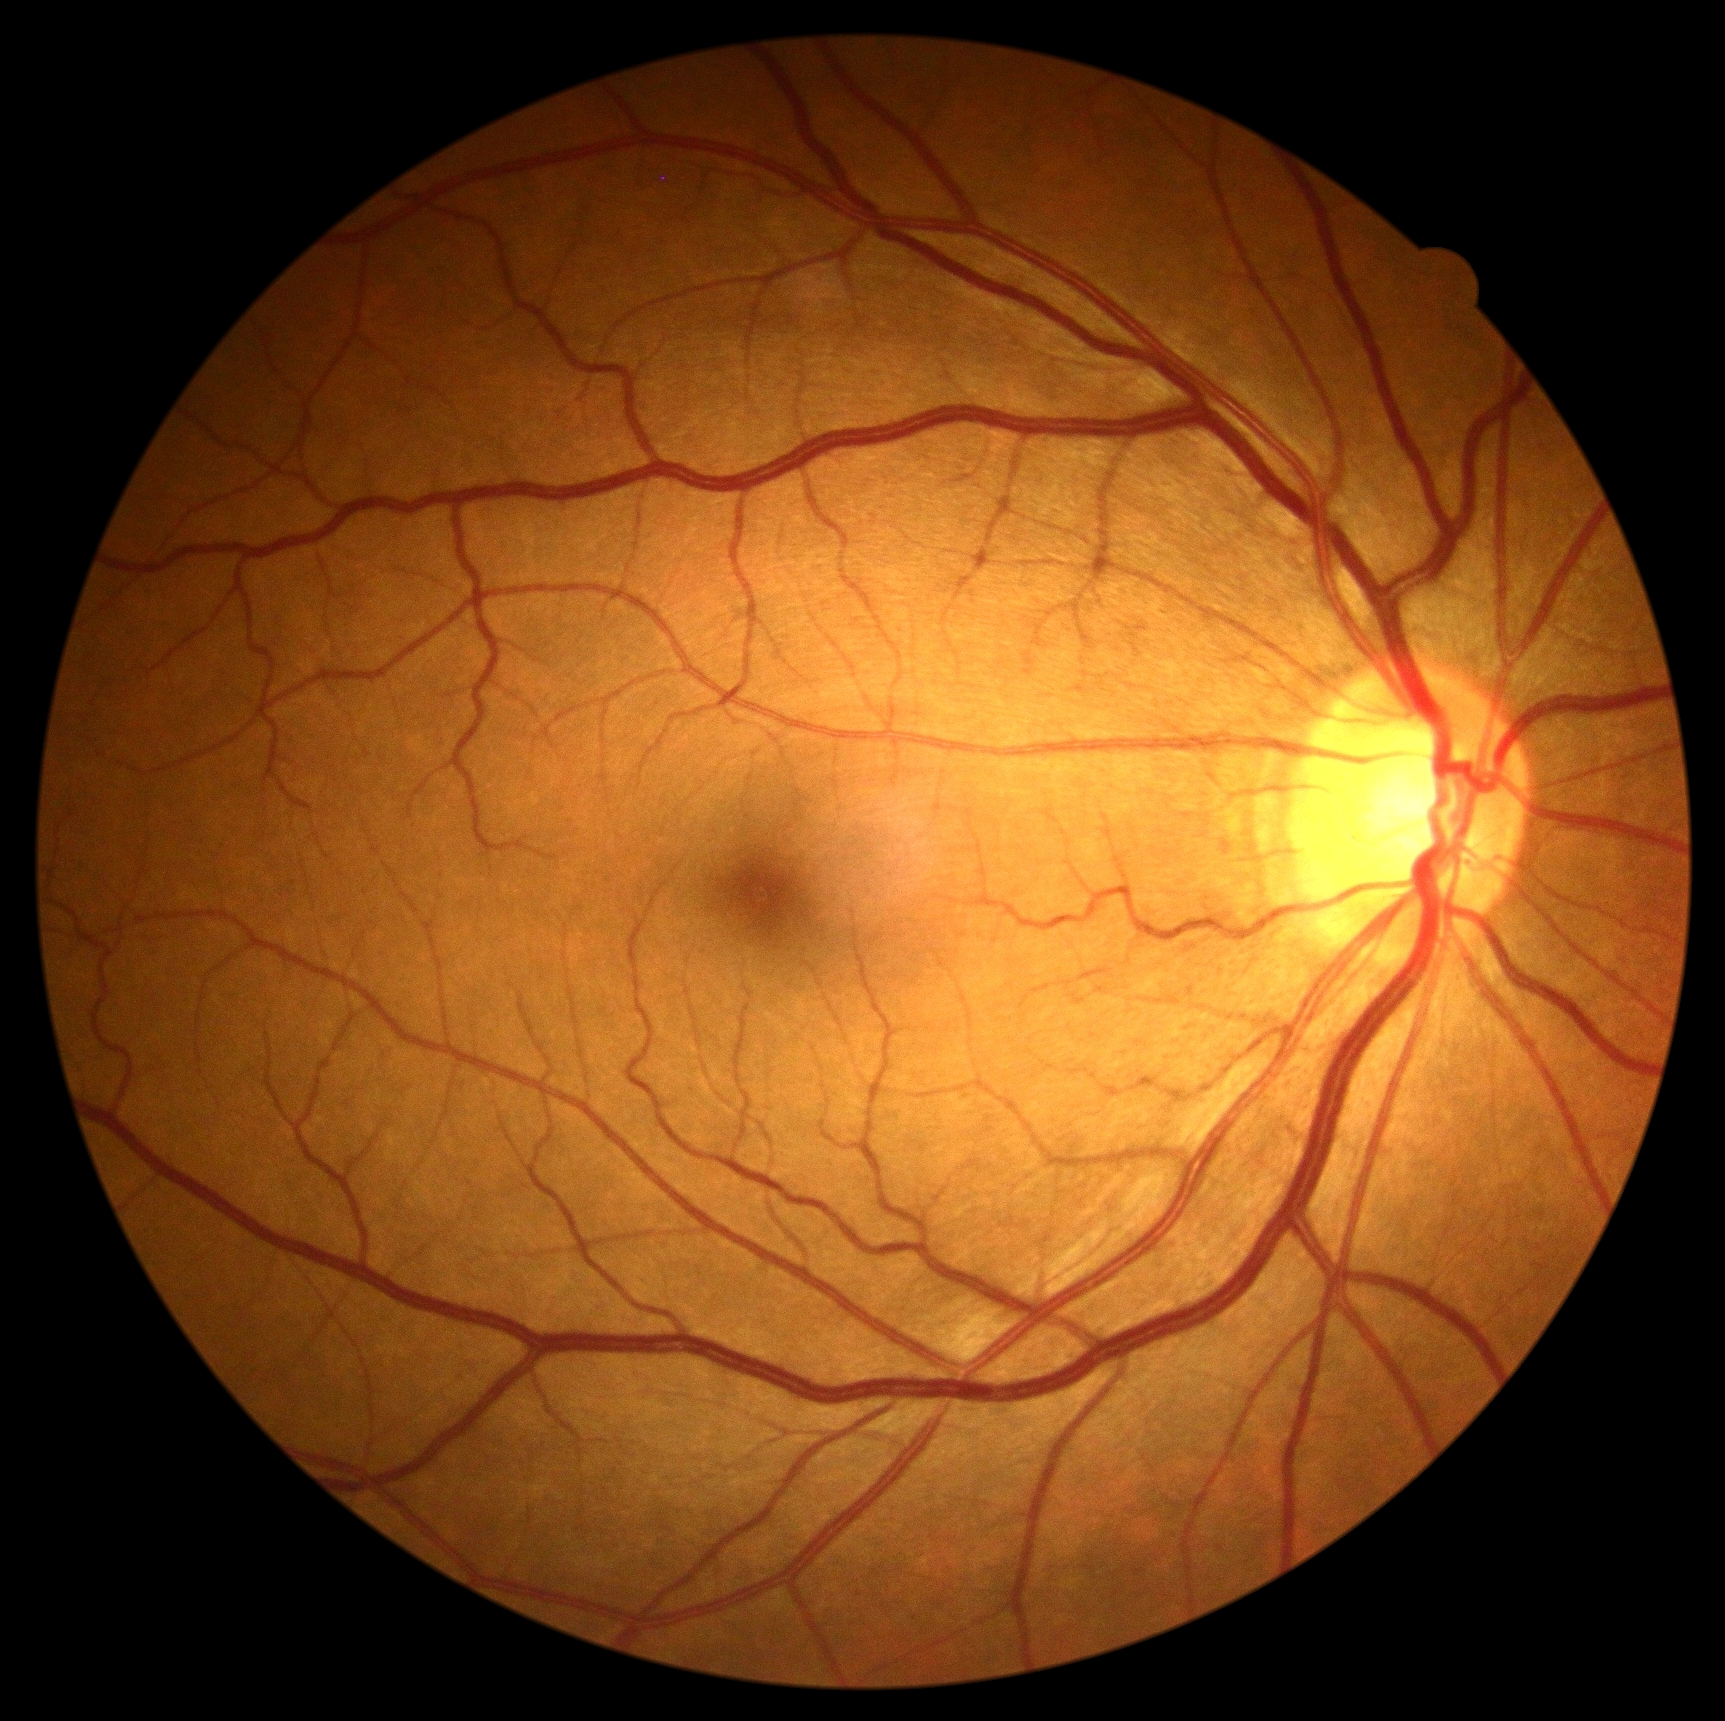
Retinopathy grade: no apparent retinopathy (0).